Color fundus image — 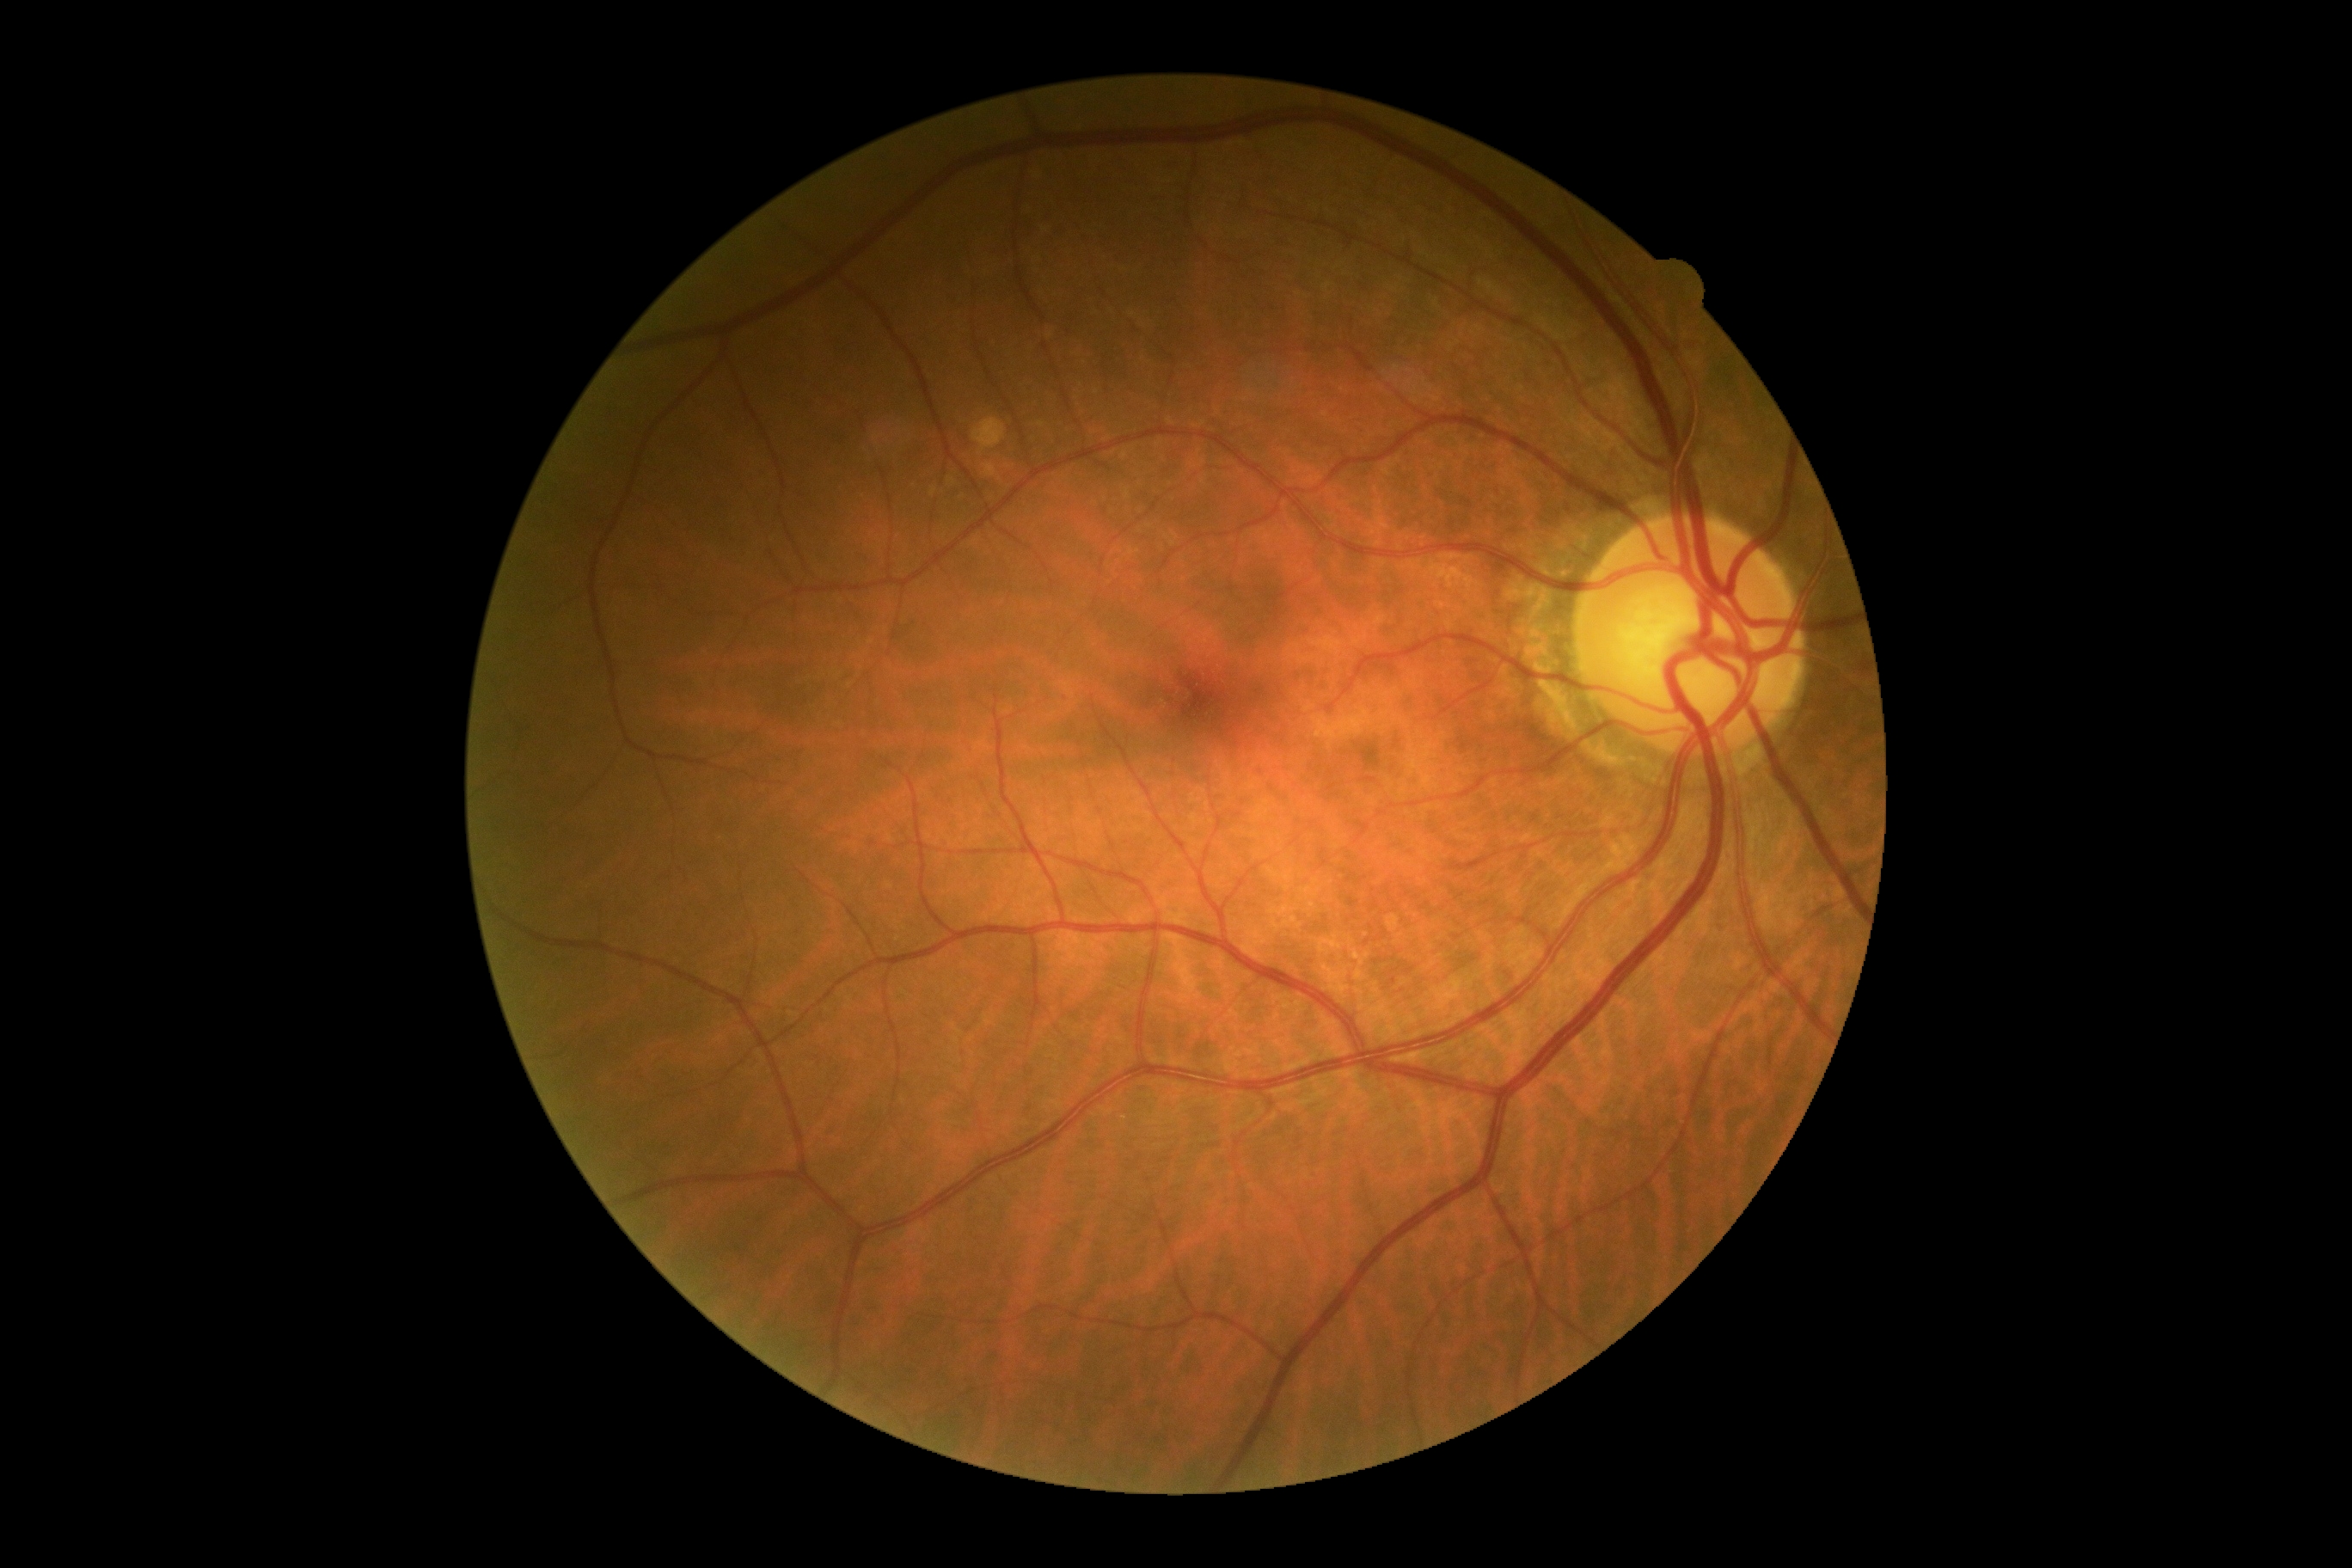 DR impression=no apparent DR; retinopathy=grade 0 (no apparent retinopathy).